45° field of view — 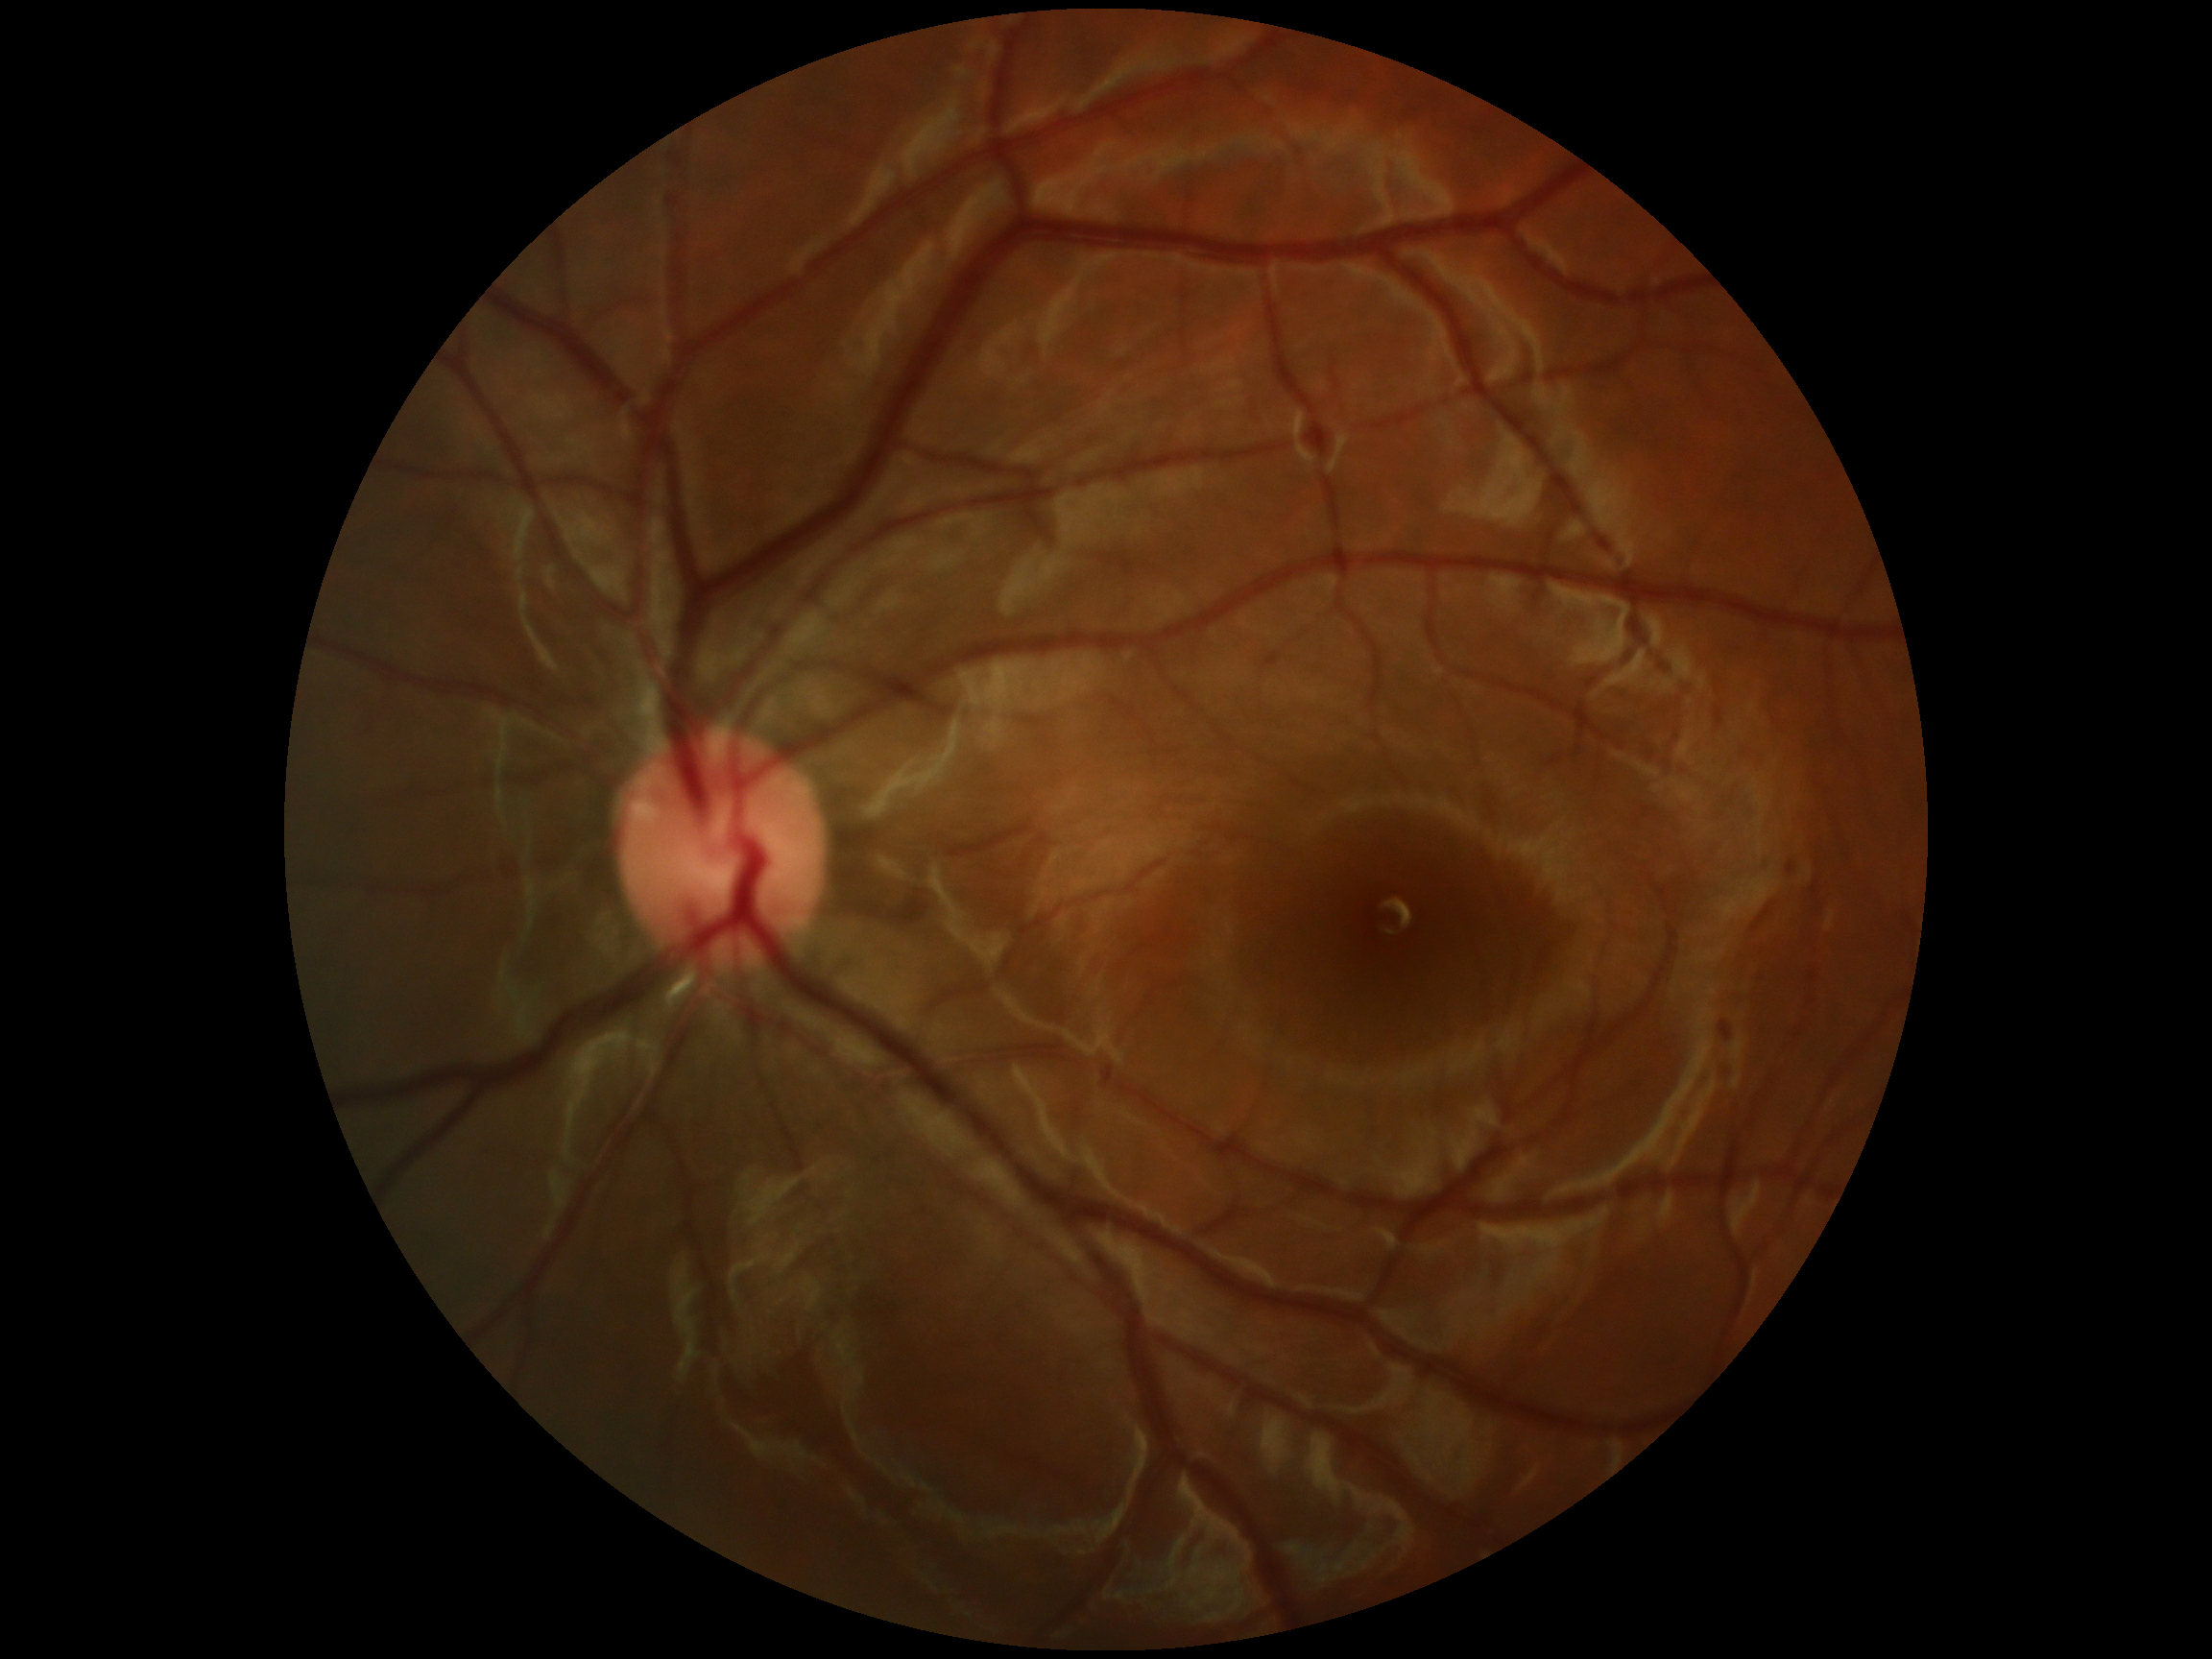
- DR severity: 0
- DR impression: negative for DR